Pediatric retinal photograph (wide-field)
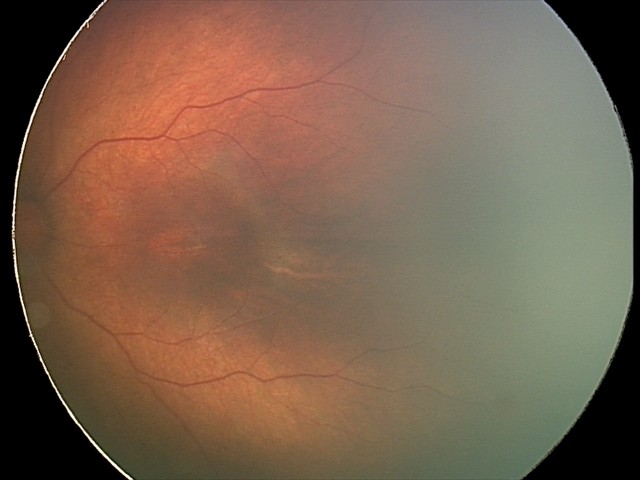

From an examination with diagnosis of status post ROP.